2048x1536px · CFP: 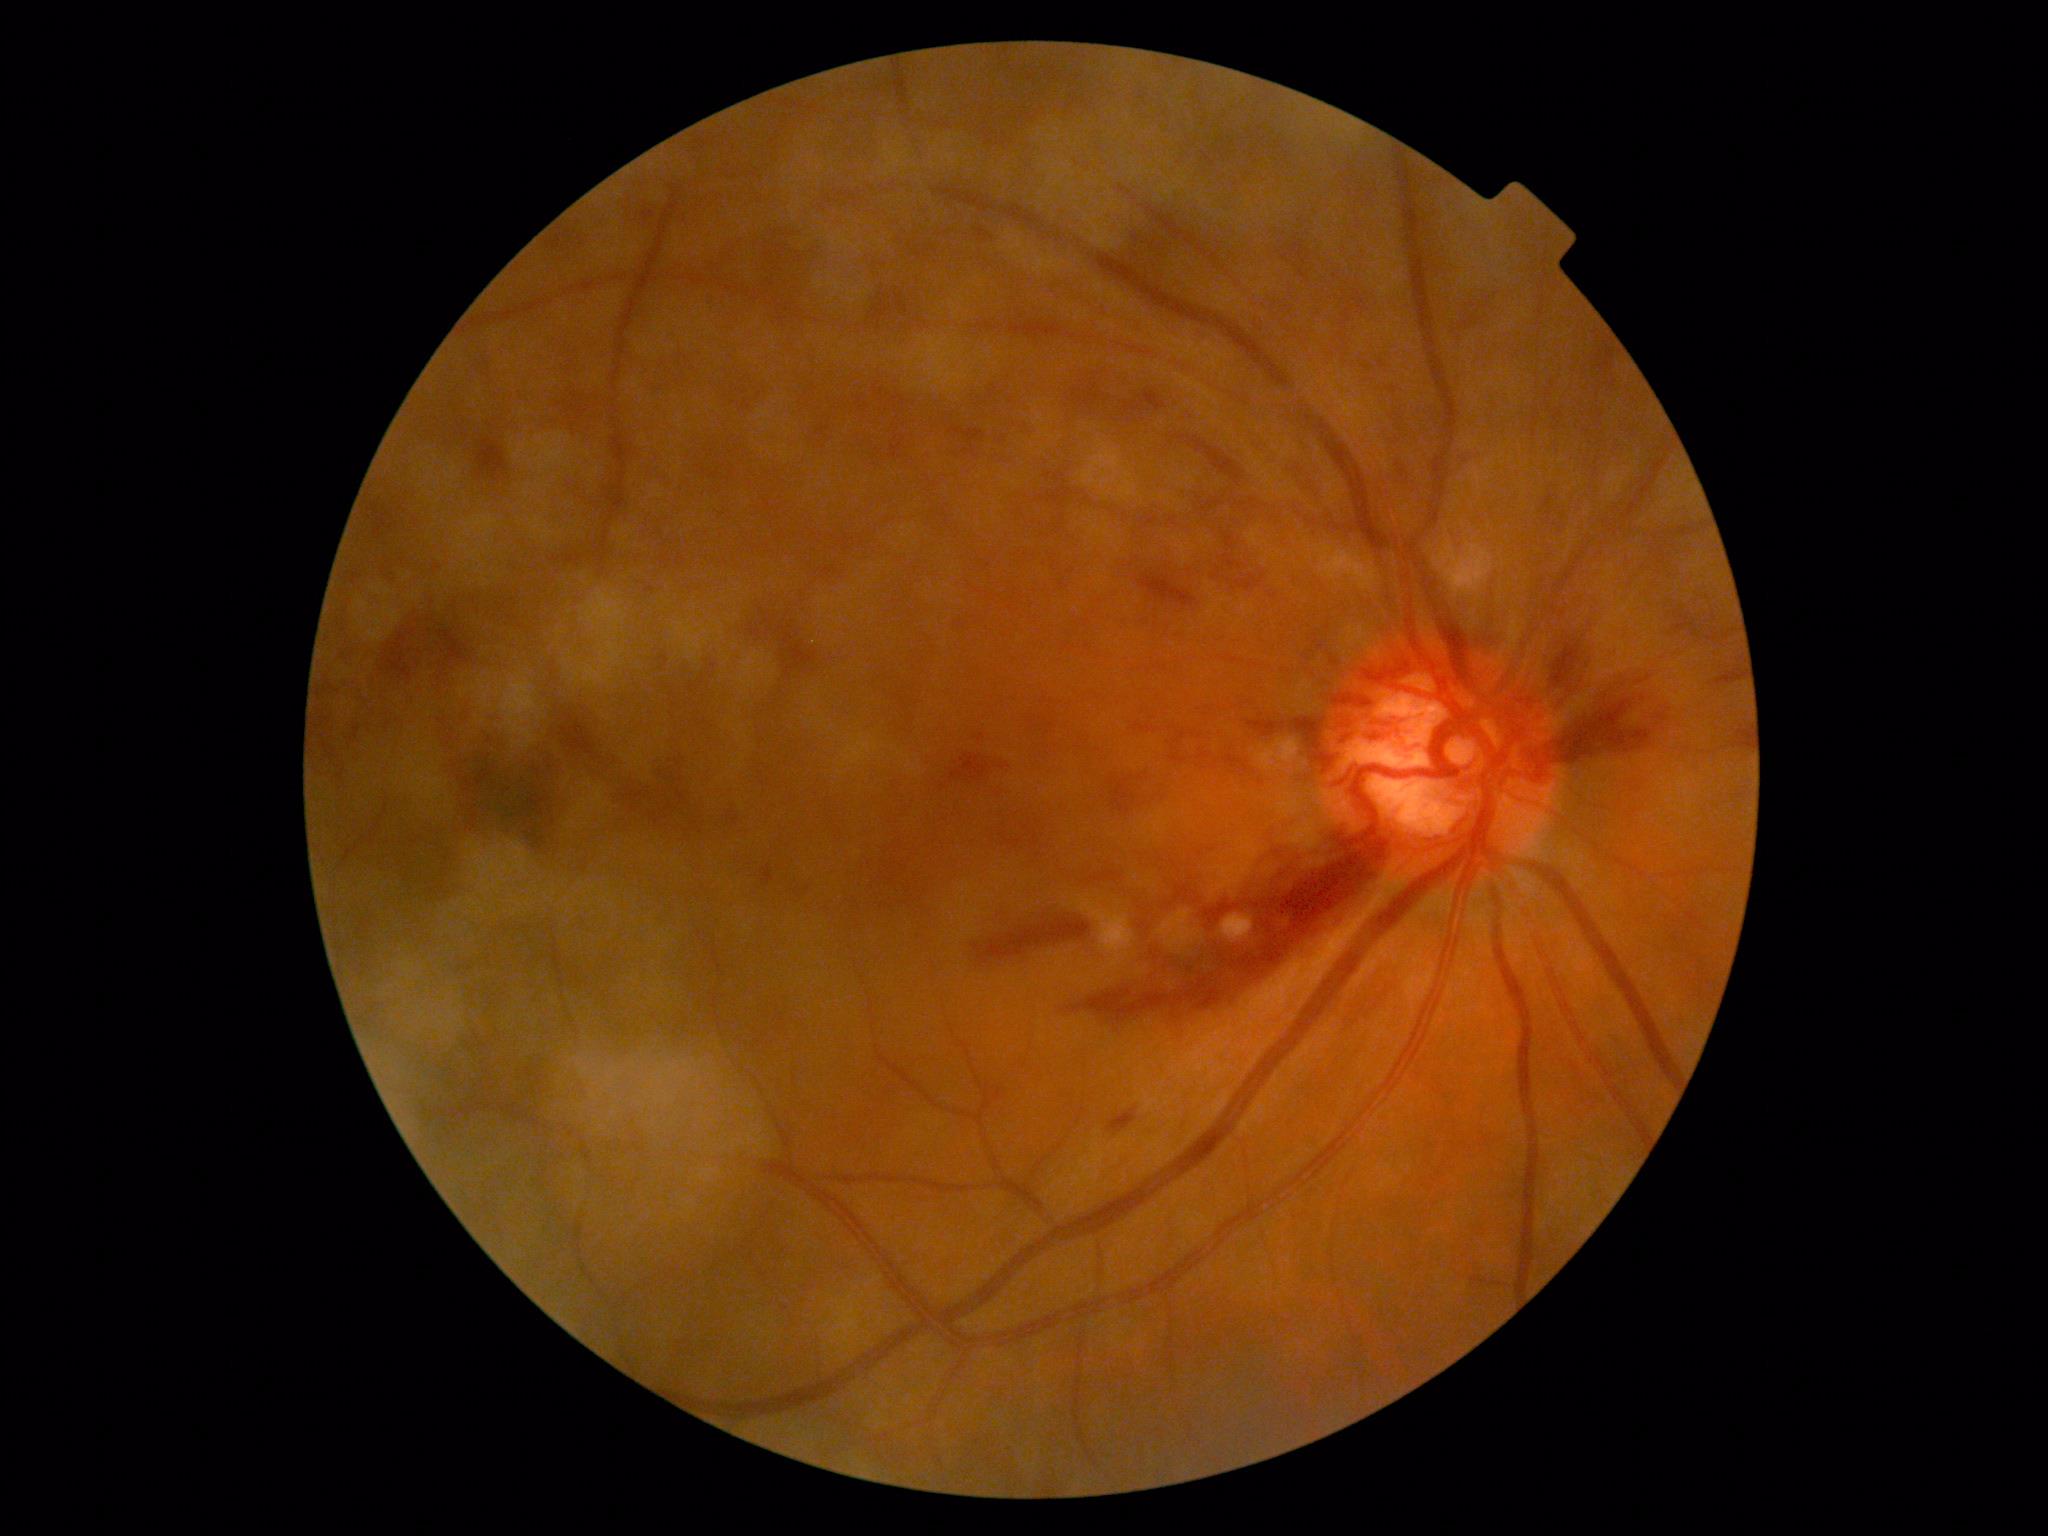 DR stage: 2 — more than just microaneurysms but less than severe NPDR.